Image size 412x310; tabletop color fundus camera image
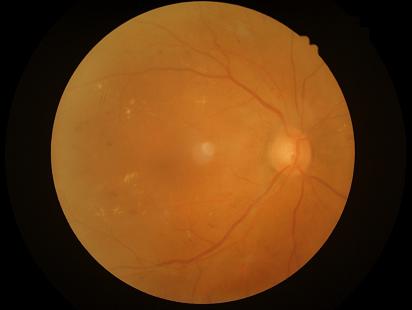

Quality grading: clarity: optic disc, vessels, and background in focus | contrast: good dynamic range | overall: adequate for clinical interpretation | illumination/color: good illumination and color balance.